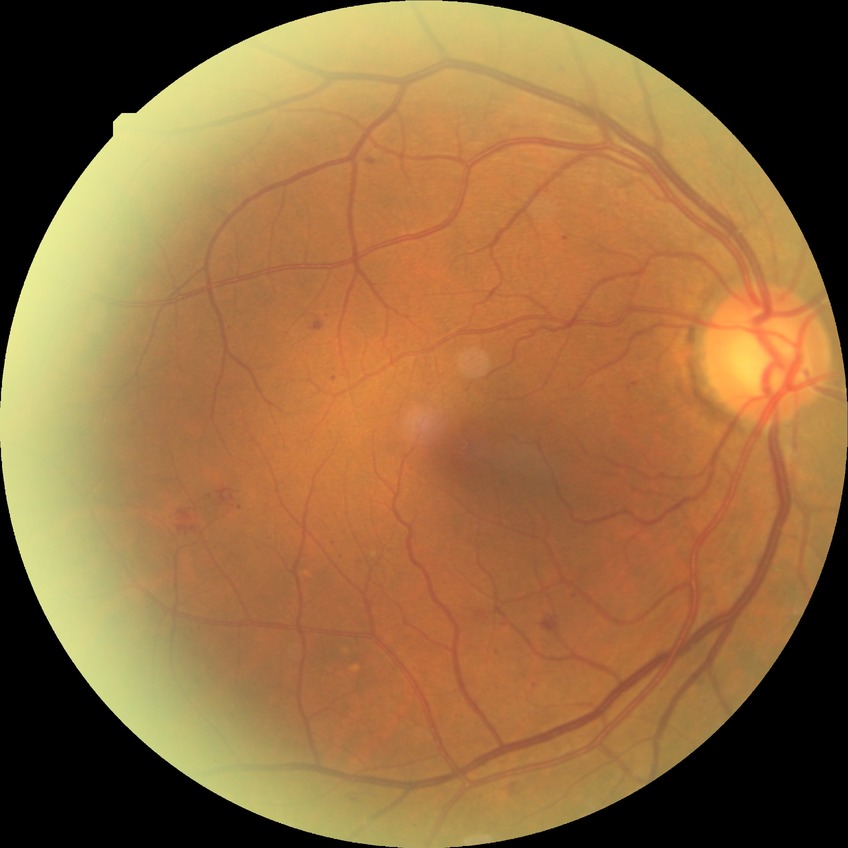
Assessment:
- diabetic retinopathy severity: simple diabetic retinopathy